Retinal fundus photograph · 512 by 512 pixels:
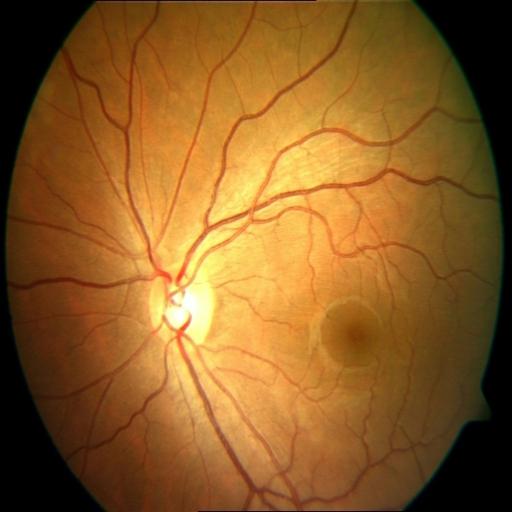
Pathology: central serous retinopathy (CSR).